Retinal fundus photograph, 45° field of view: 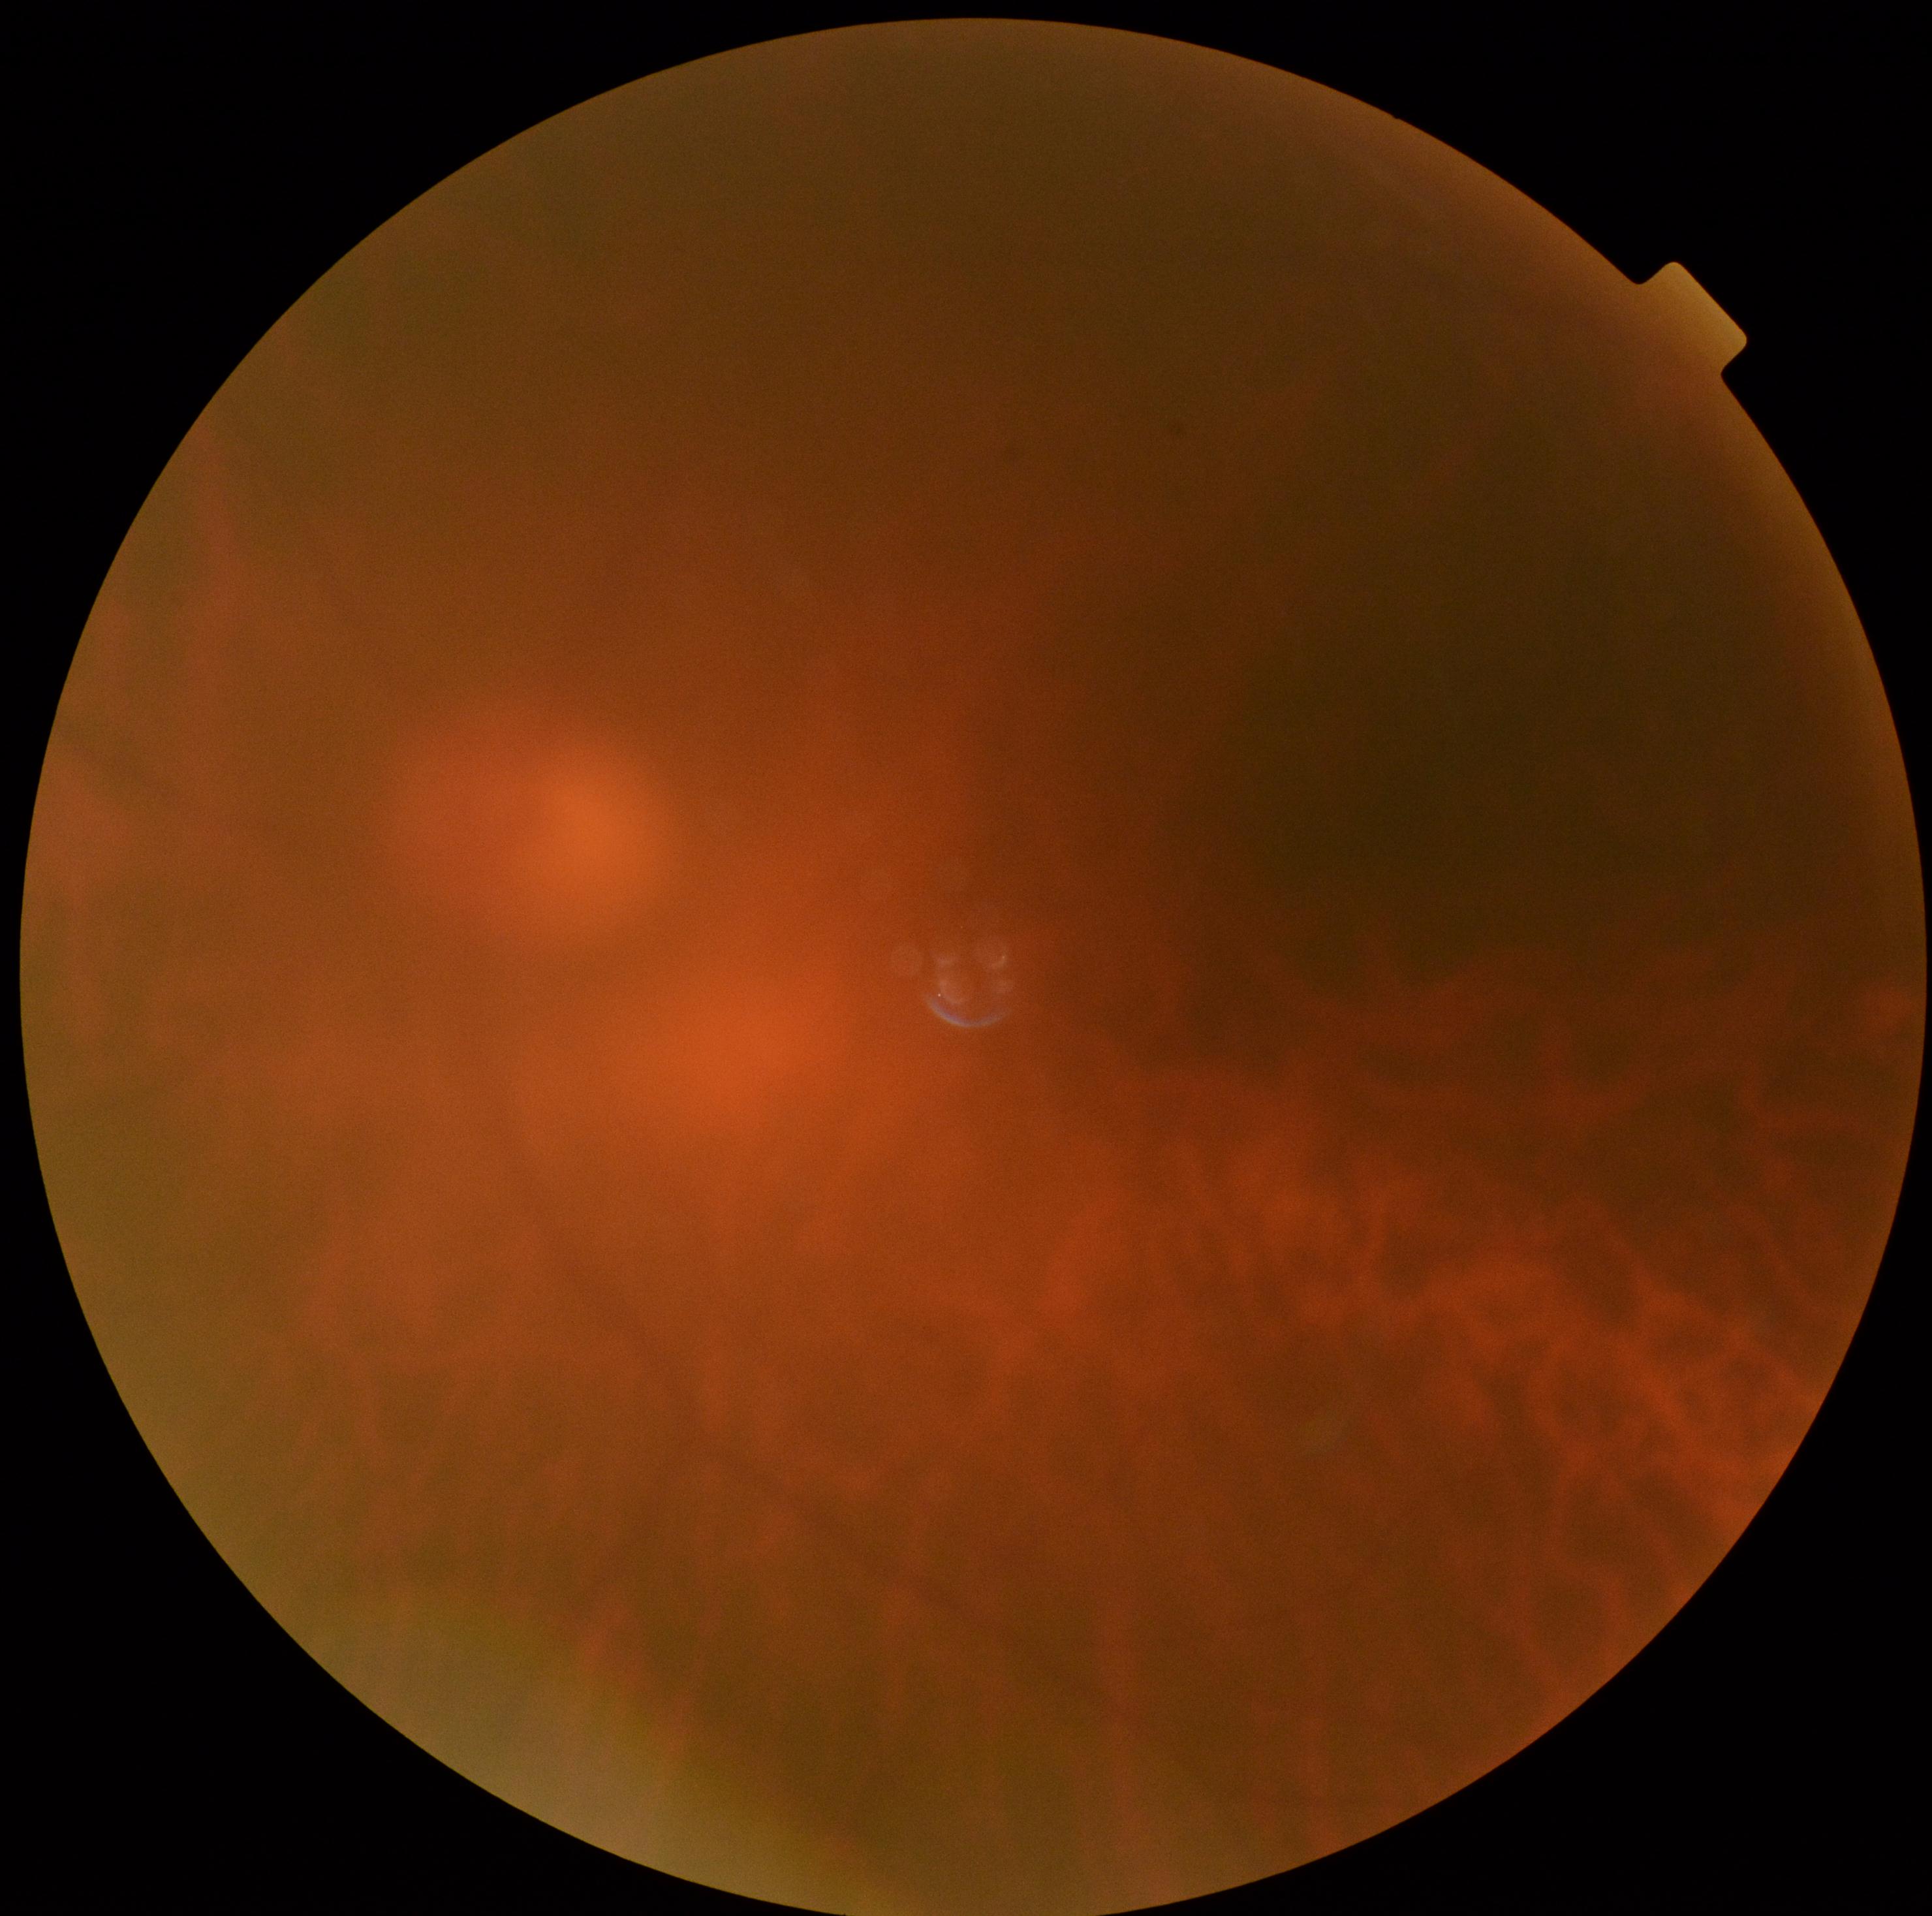
Retinopathy is 0/4. No DR findings.